240 by 240 pixels
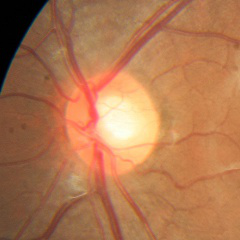 No evidence of glaucoma.